Retinal fundus photograph · 1725x1721.
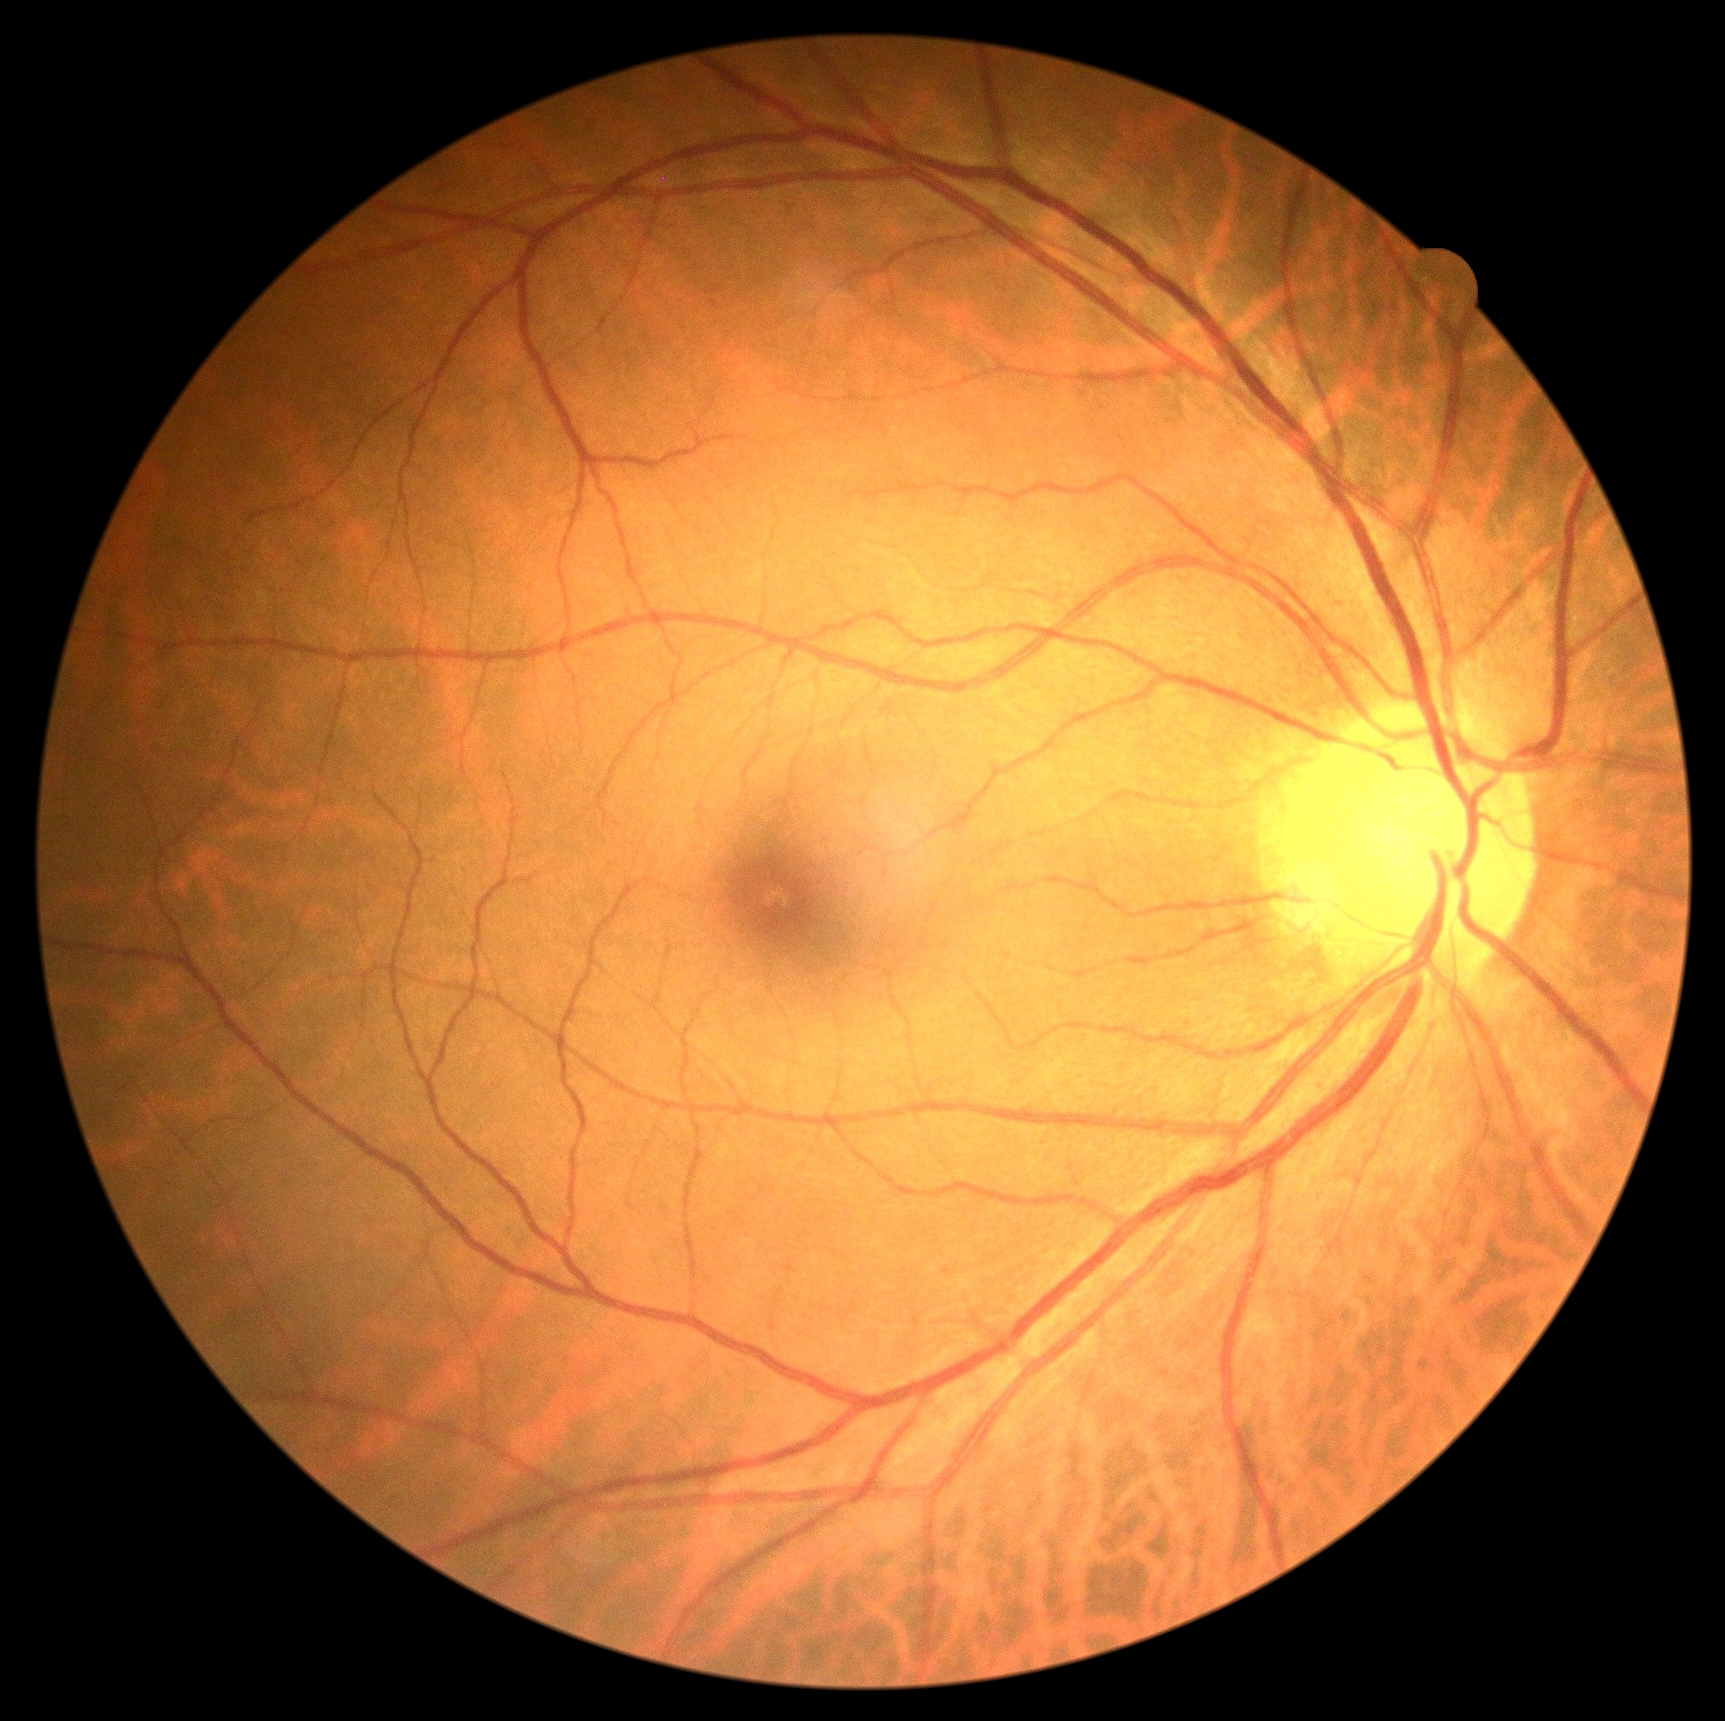

DR severity: no apparent retinopathy (grade 0).